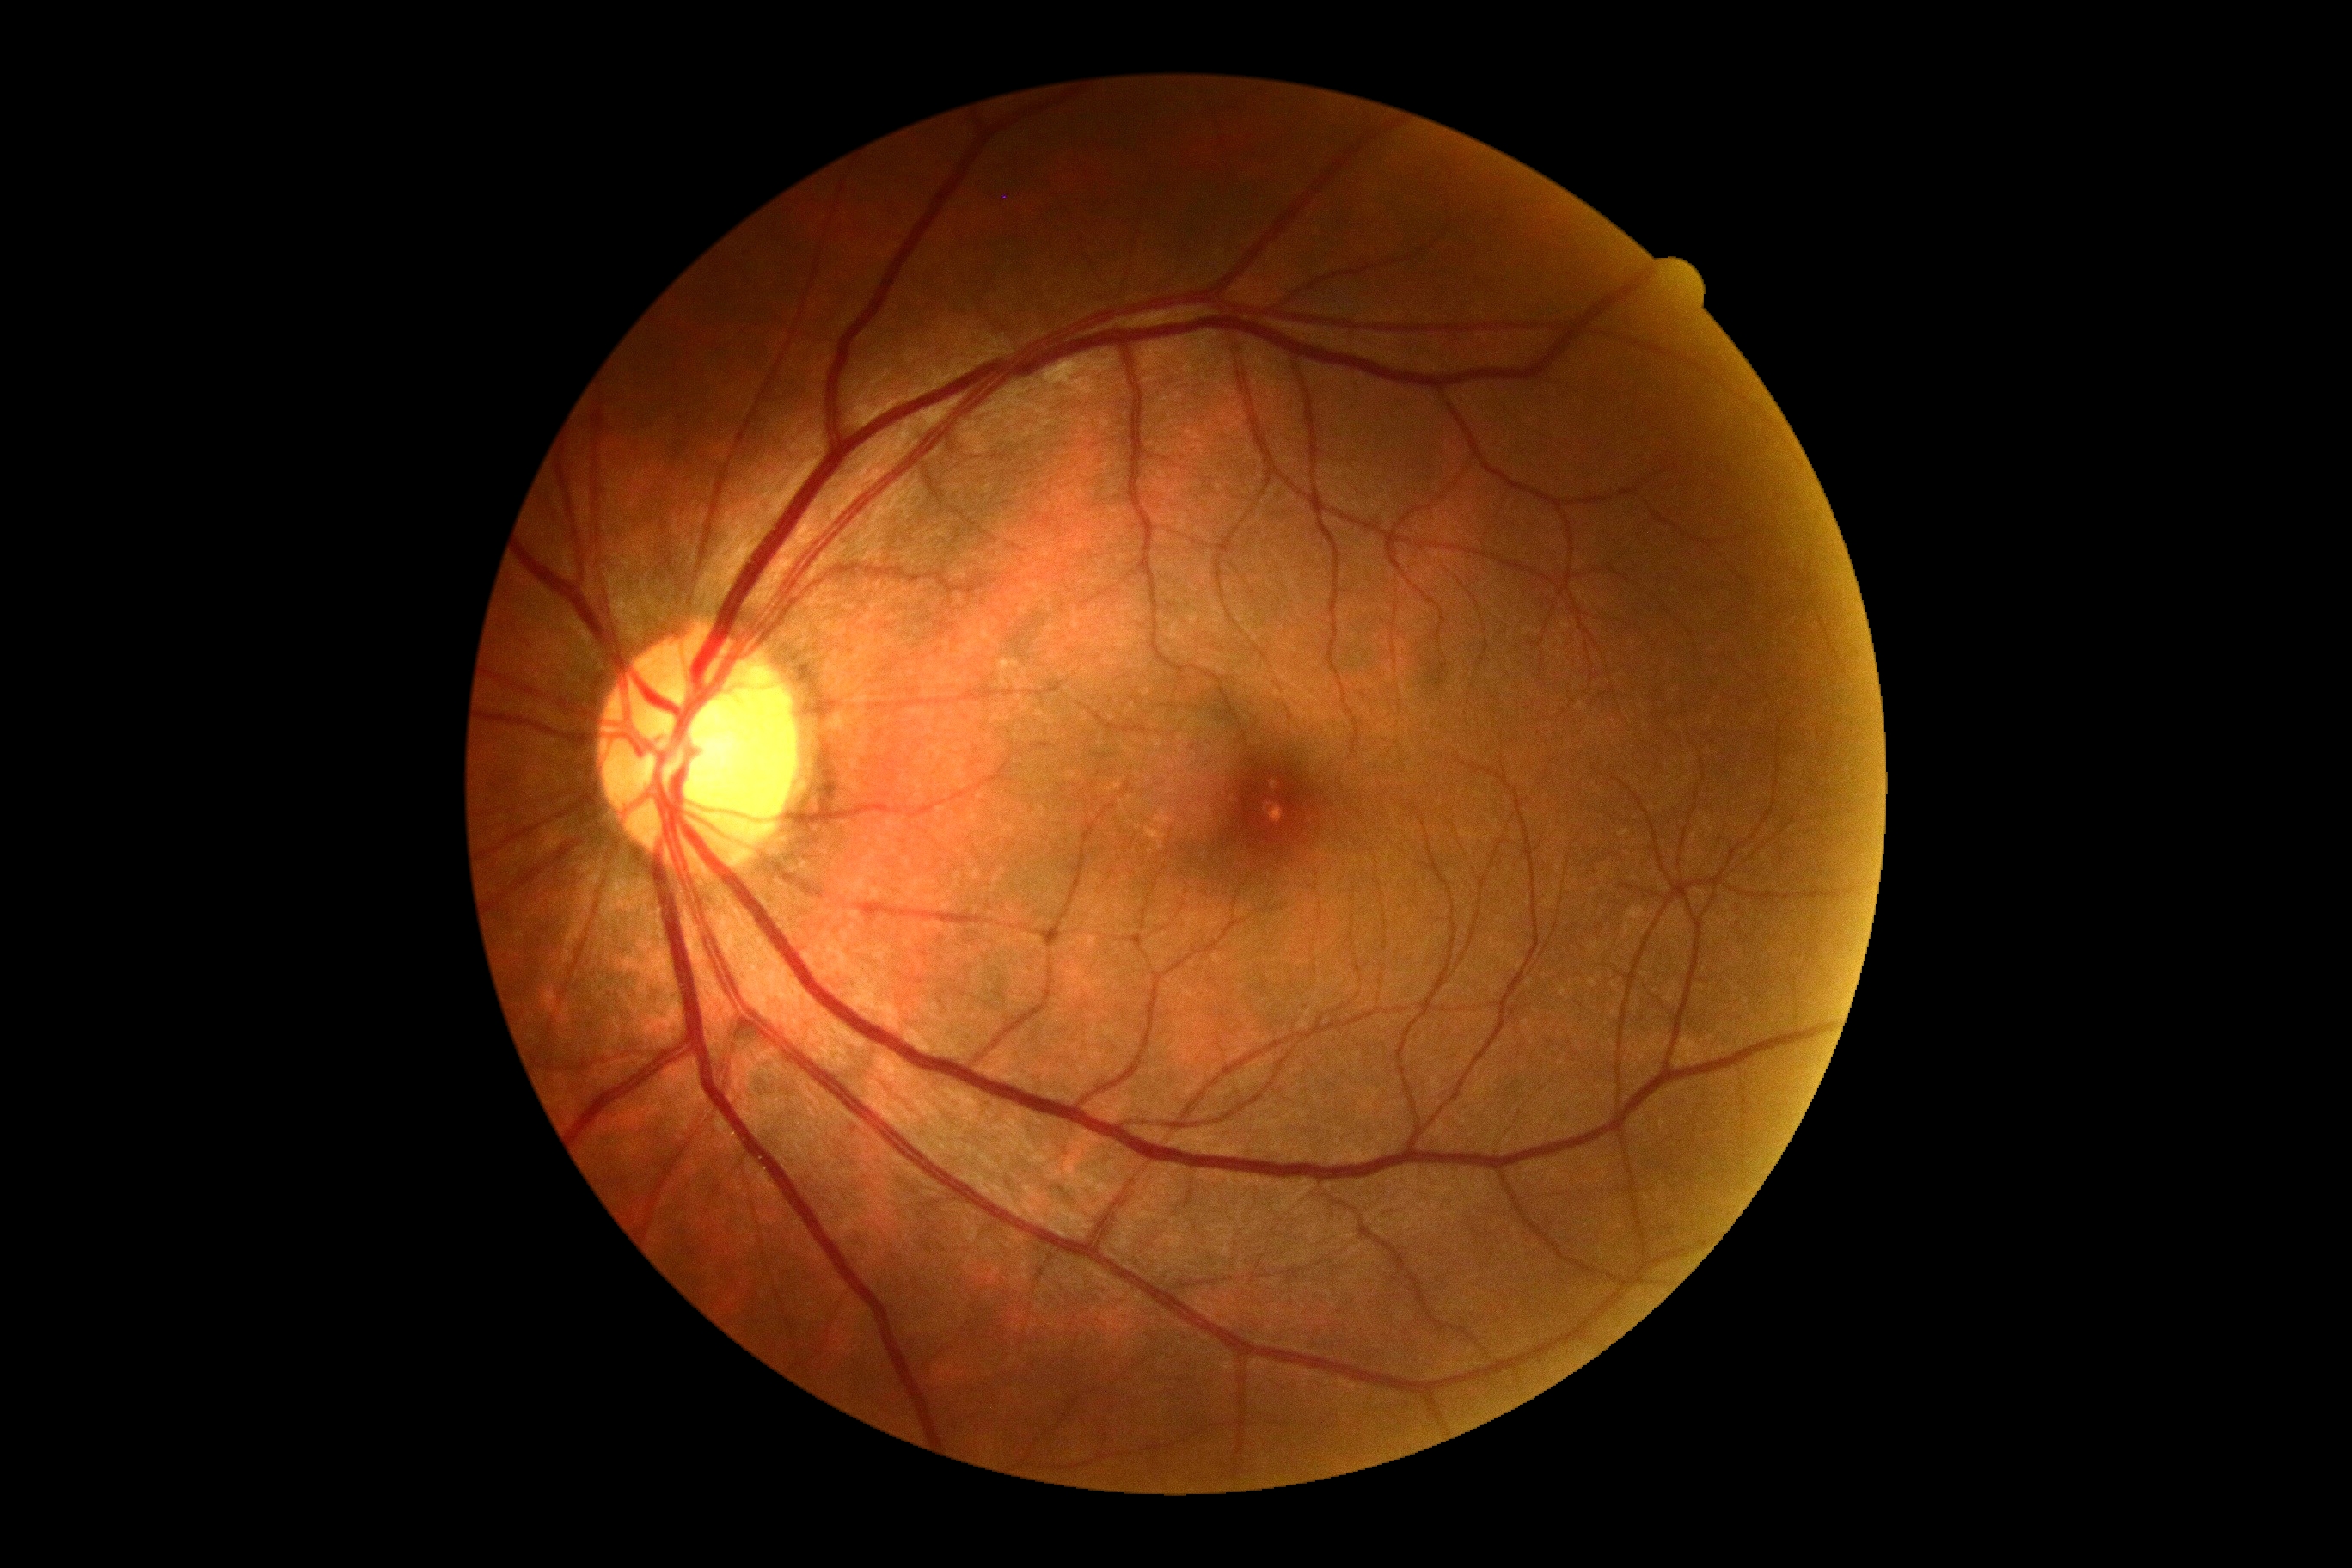 diabetic retinopathy (DR) = no apparent retinopathy (grade 0).